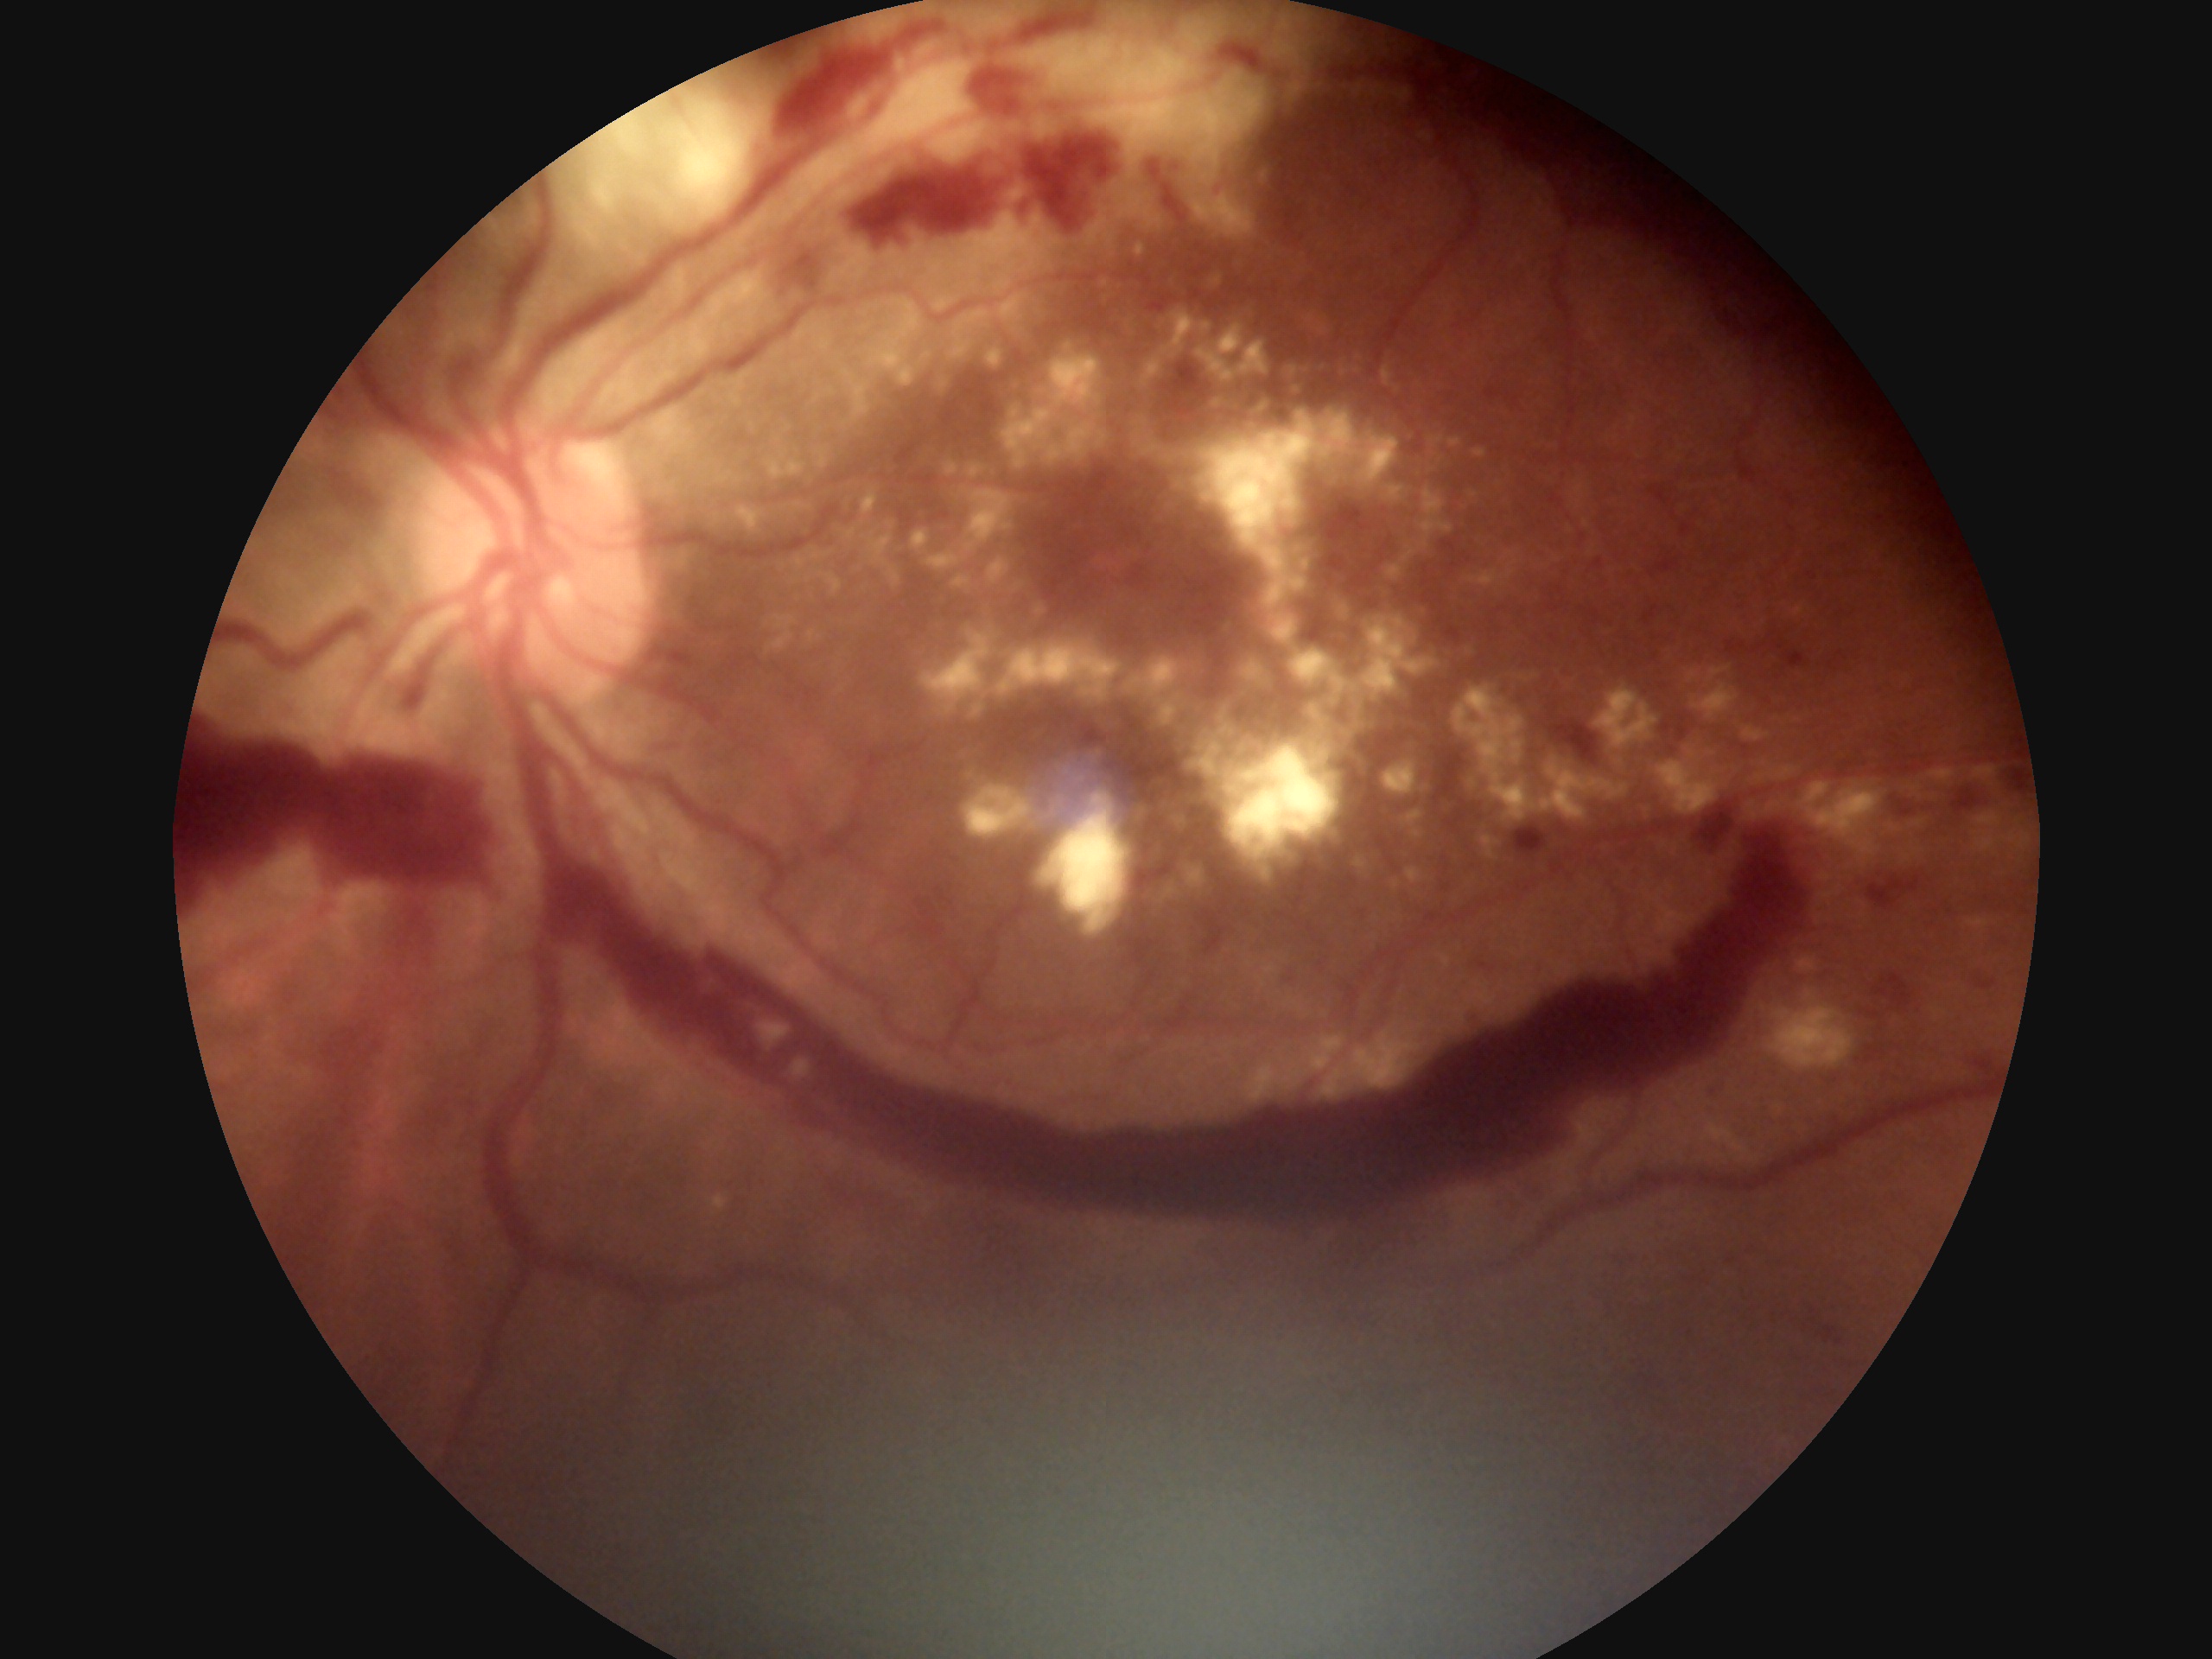 Diabetic retinopathy grade is 4/4 — neovascularization and/or vitreous/pre-retinal hemorrhage.